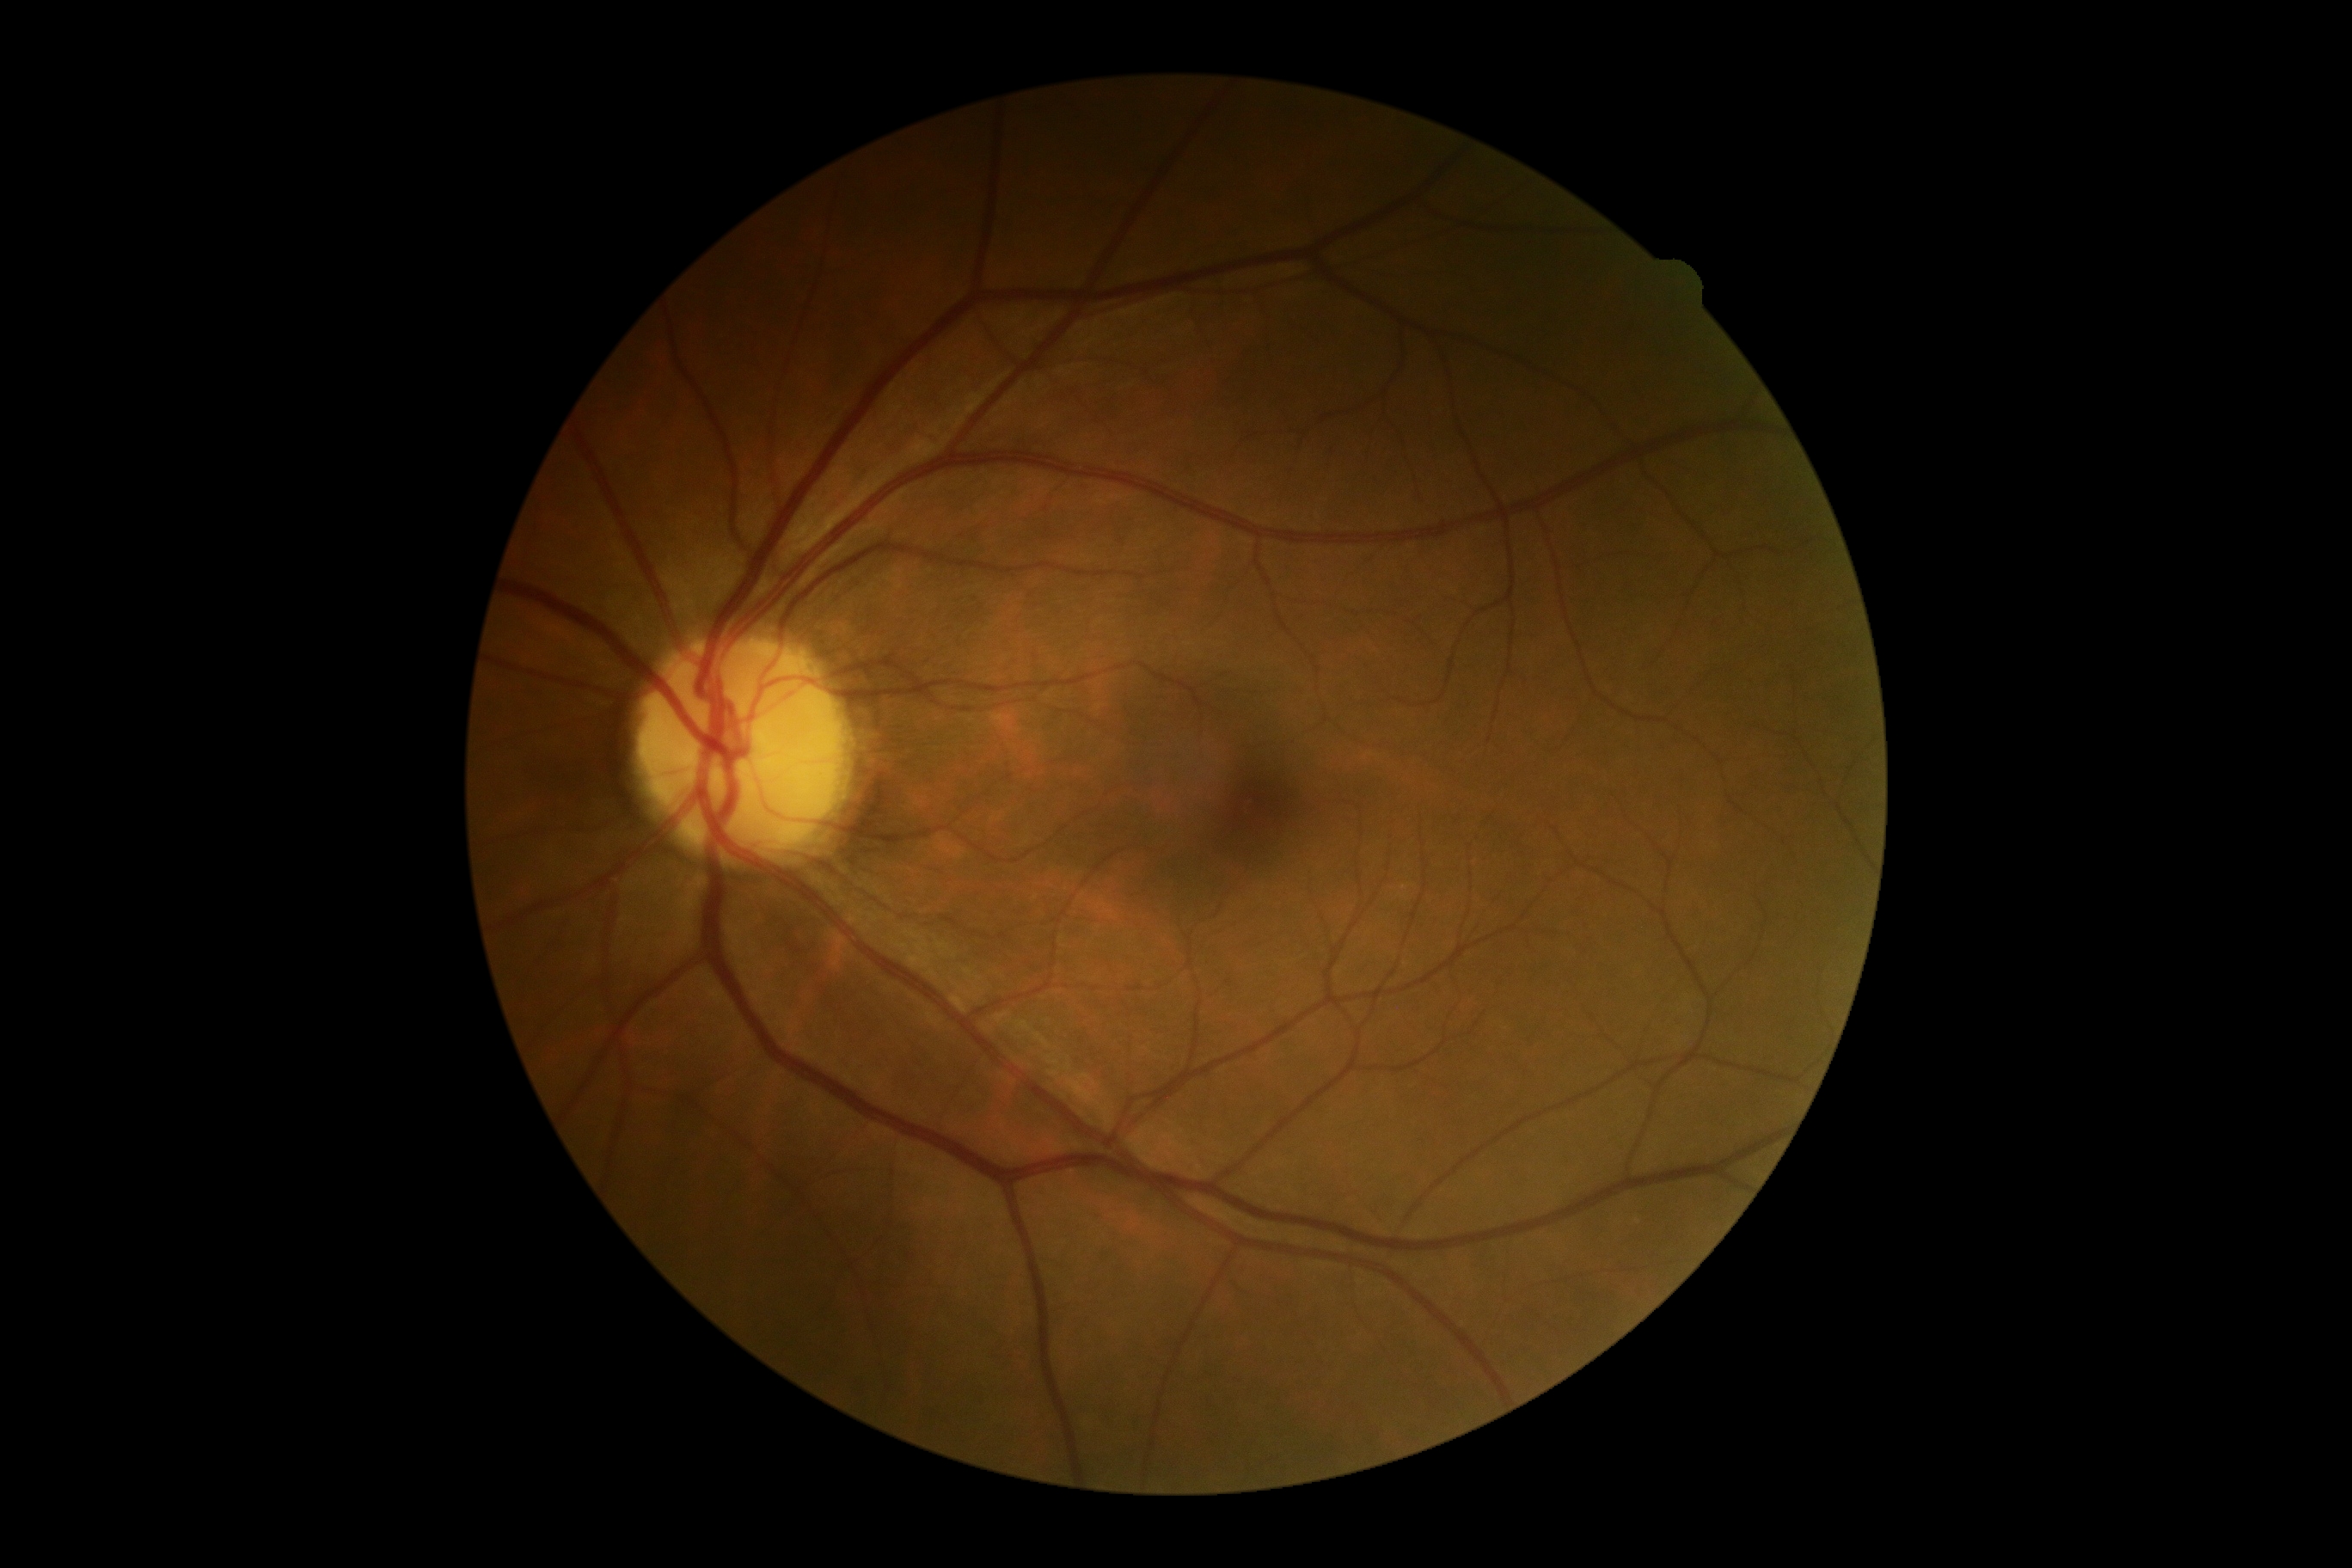

DR is grade 0 — no visible signs of diabetic retinopathy.
No diabetic retinal disease findings.